Non-mydriatic: 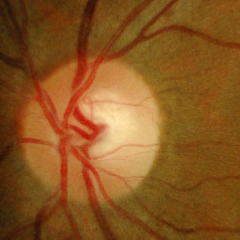

Color fundus photograph showing no glaucomatous findings.